2048x1536px:
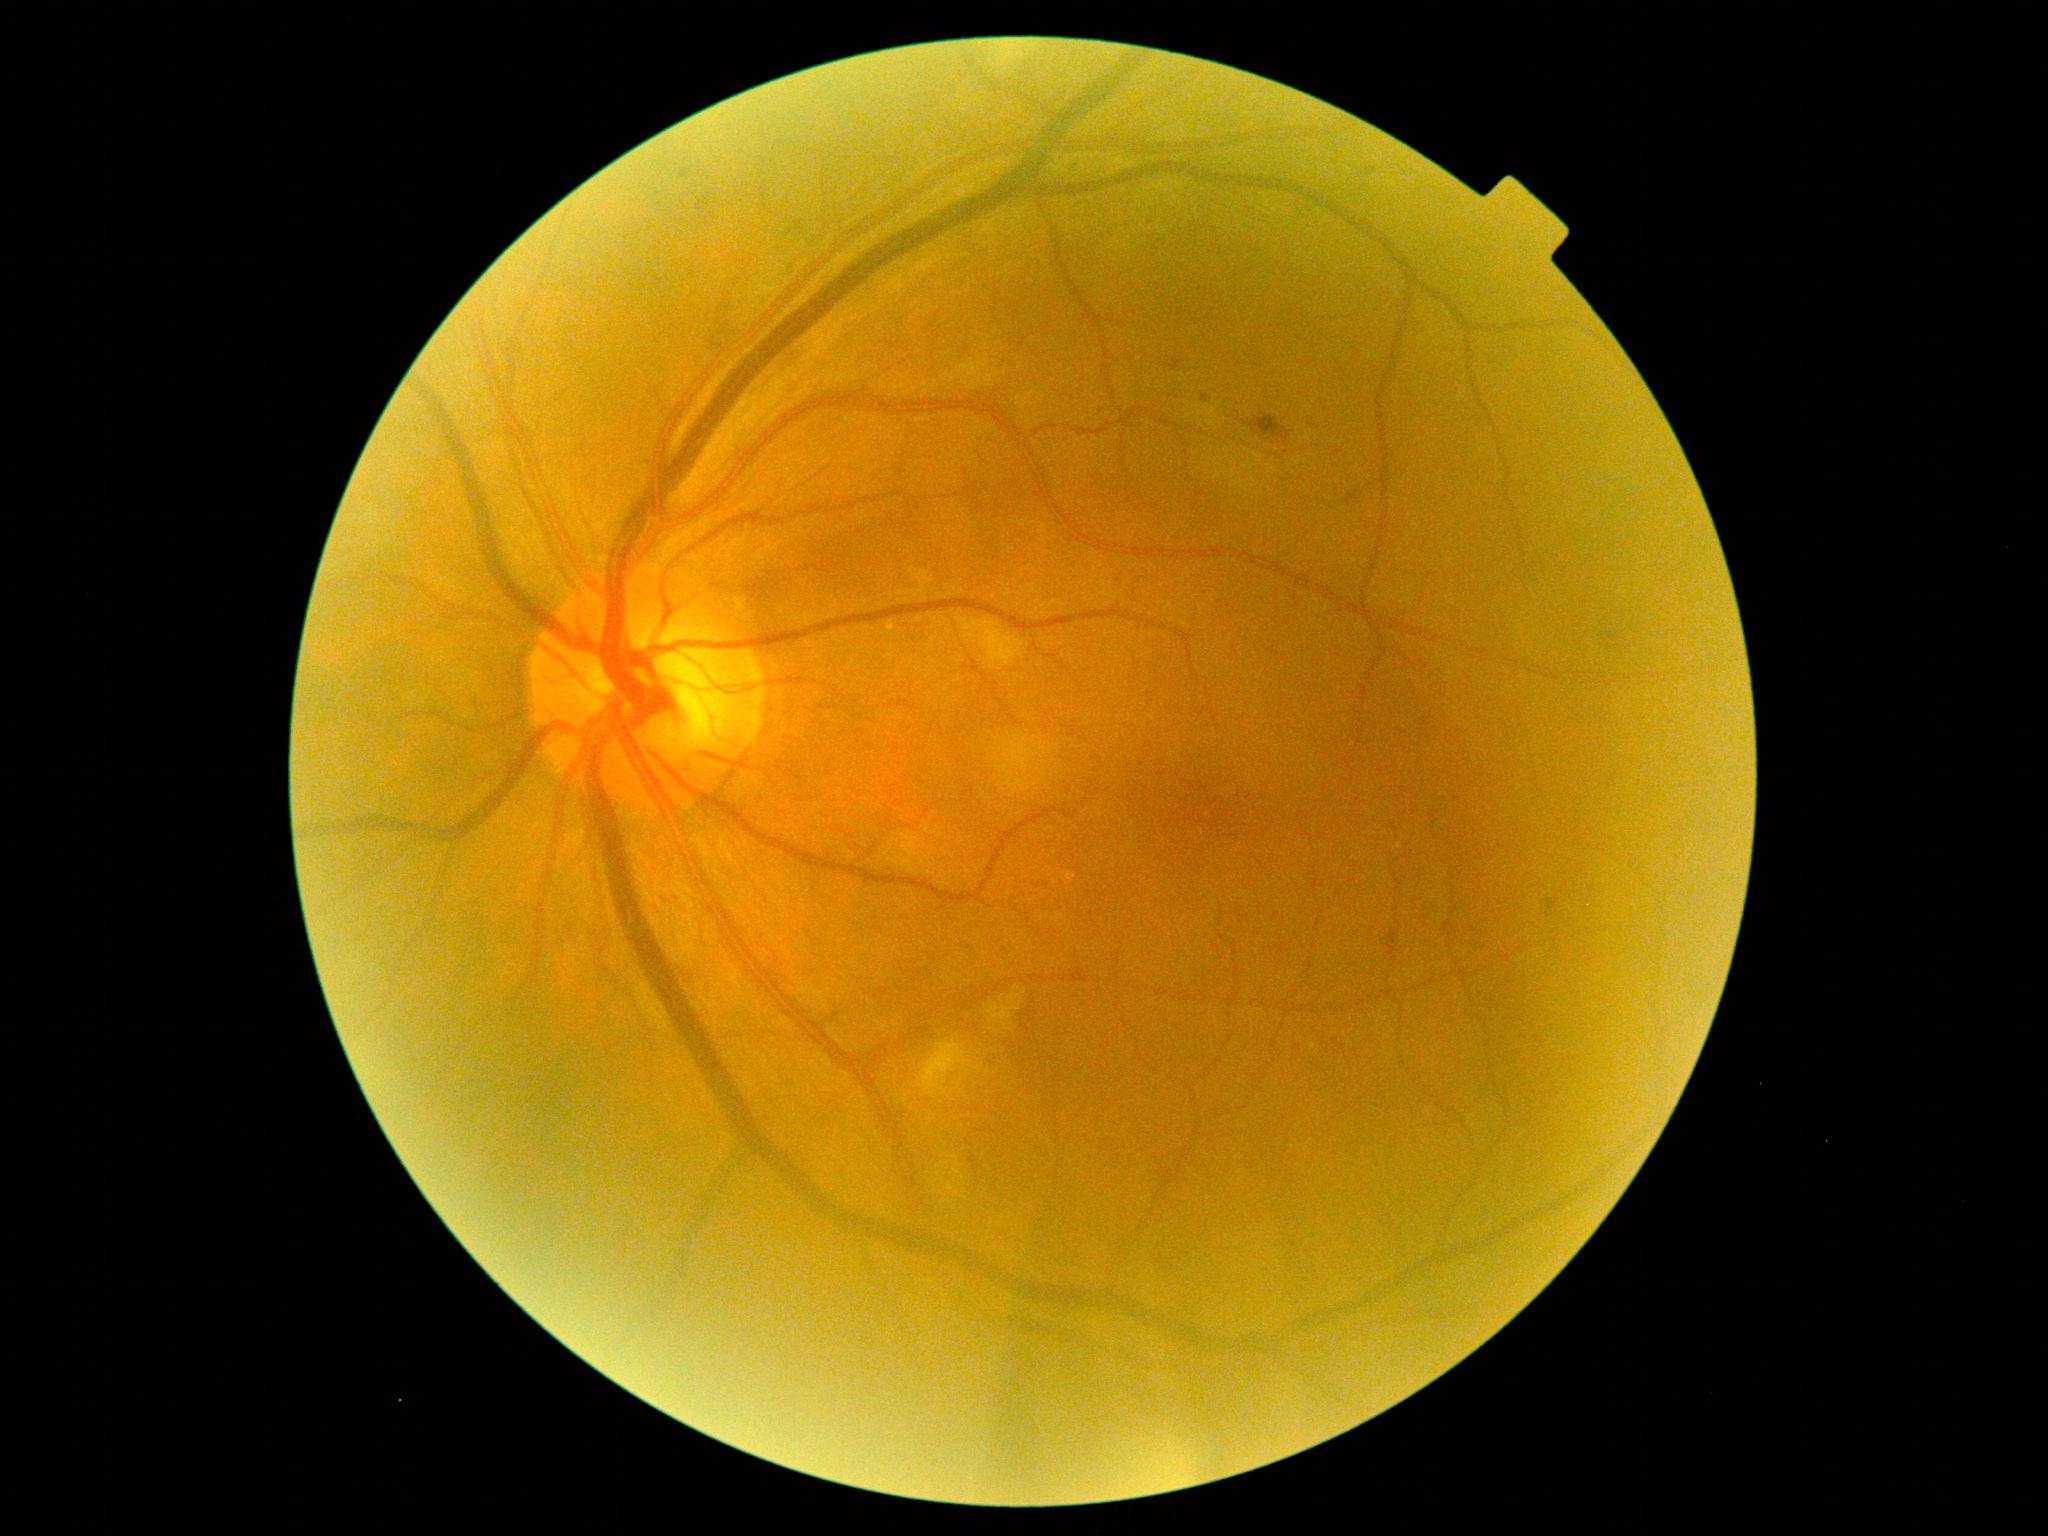

dr_grade: moderate non-proliferative diabetic retinopathy (grade 2)